Color fundus photograph · 2352x1568px.
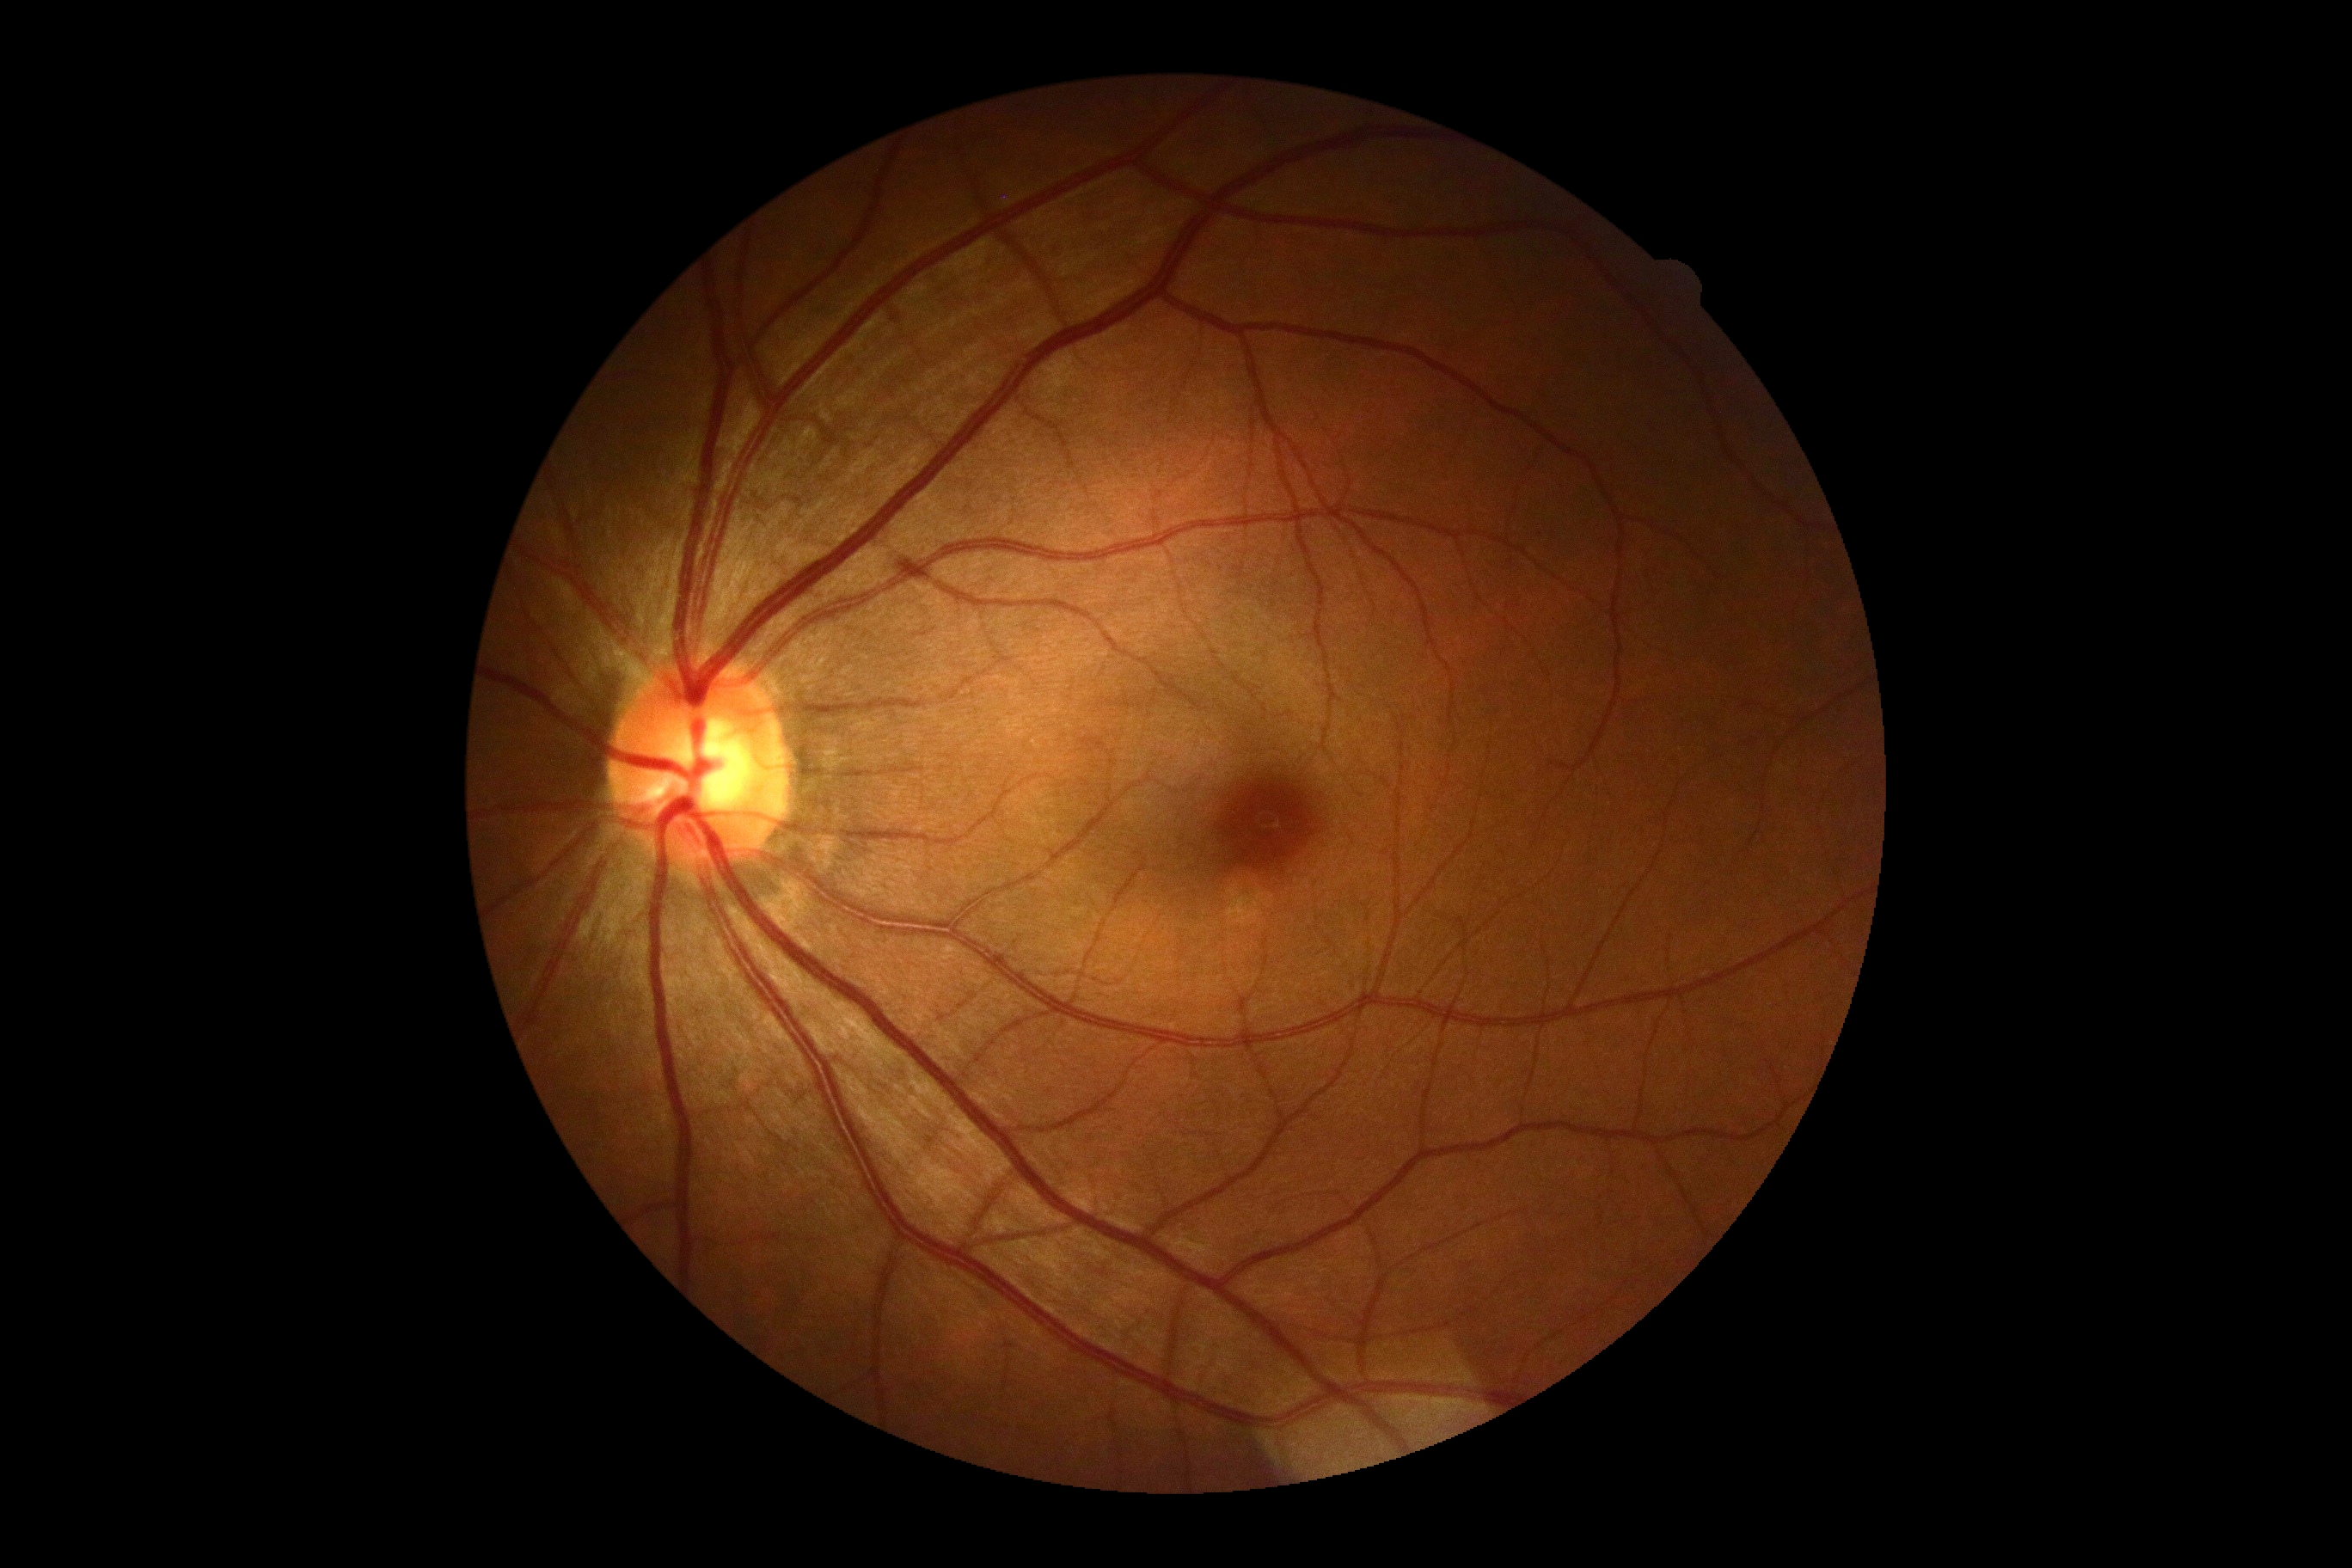 diabetic retinopathy (DR): grade 0